1504 x 1000 pixels, color fundus photograph.
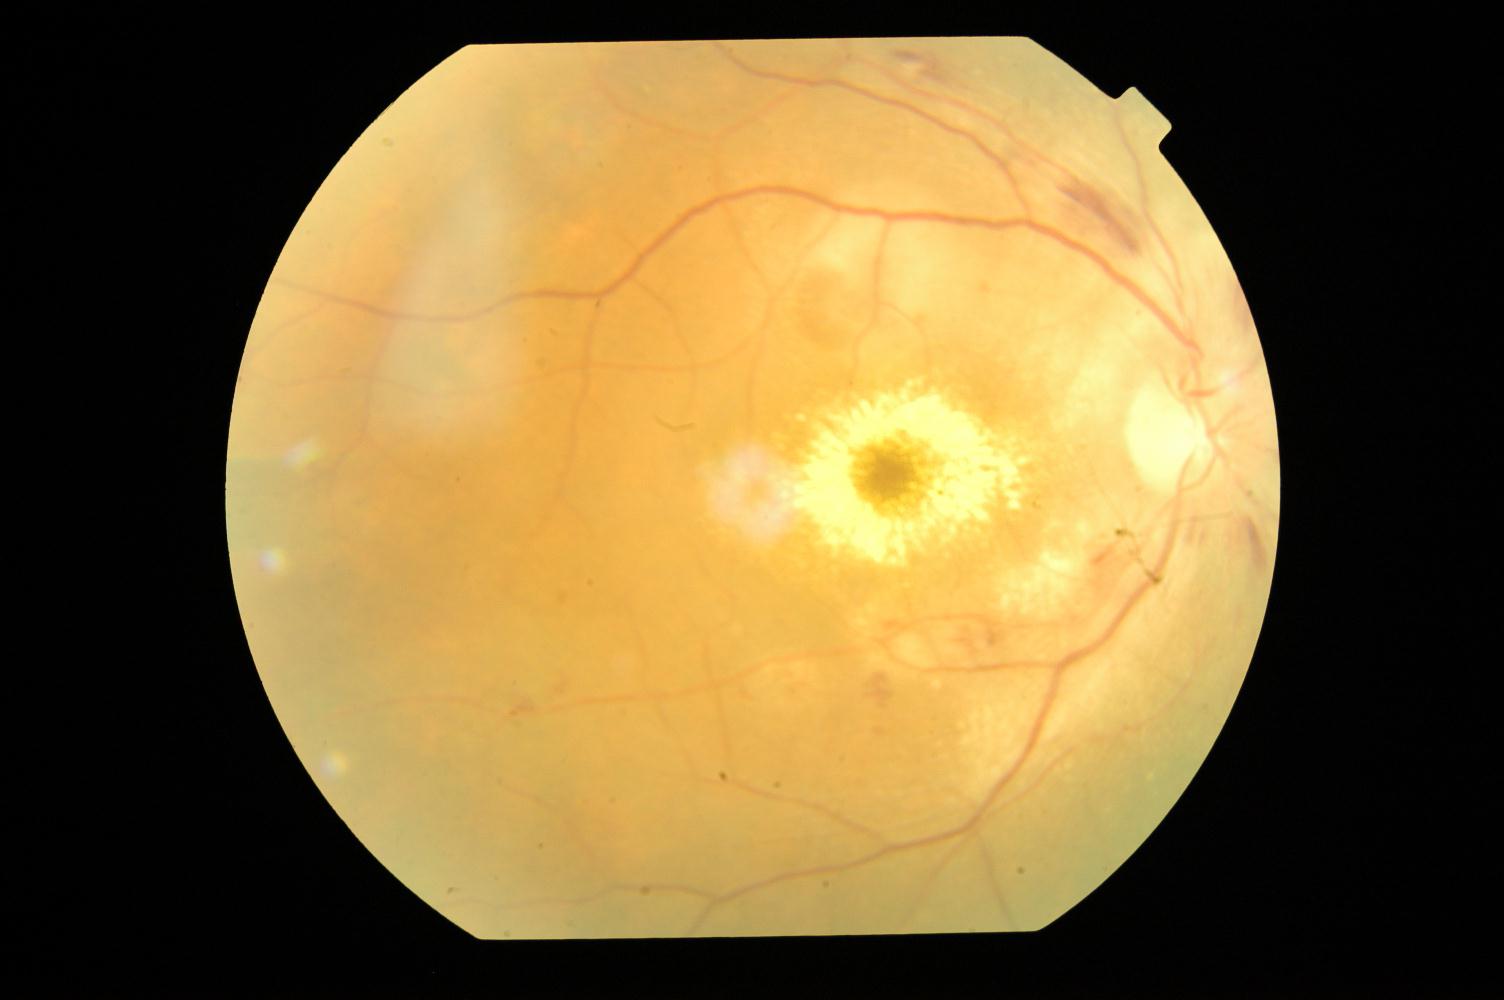 Abnormalities:
- hypertensive retinopathy (HTN)